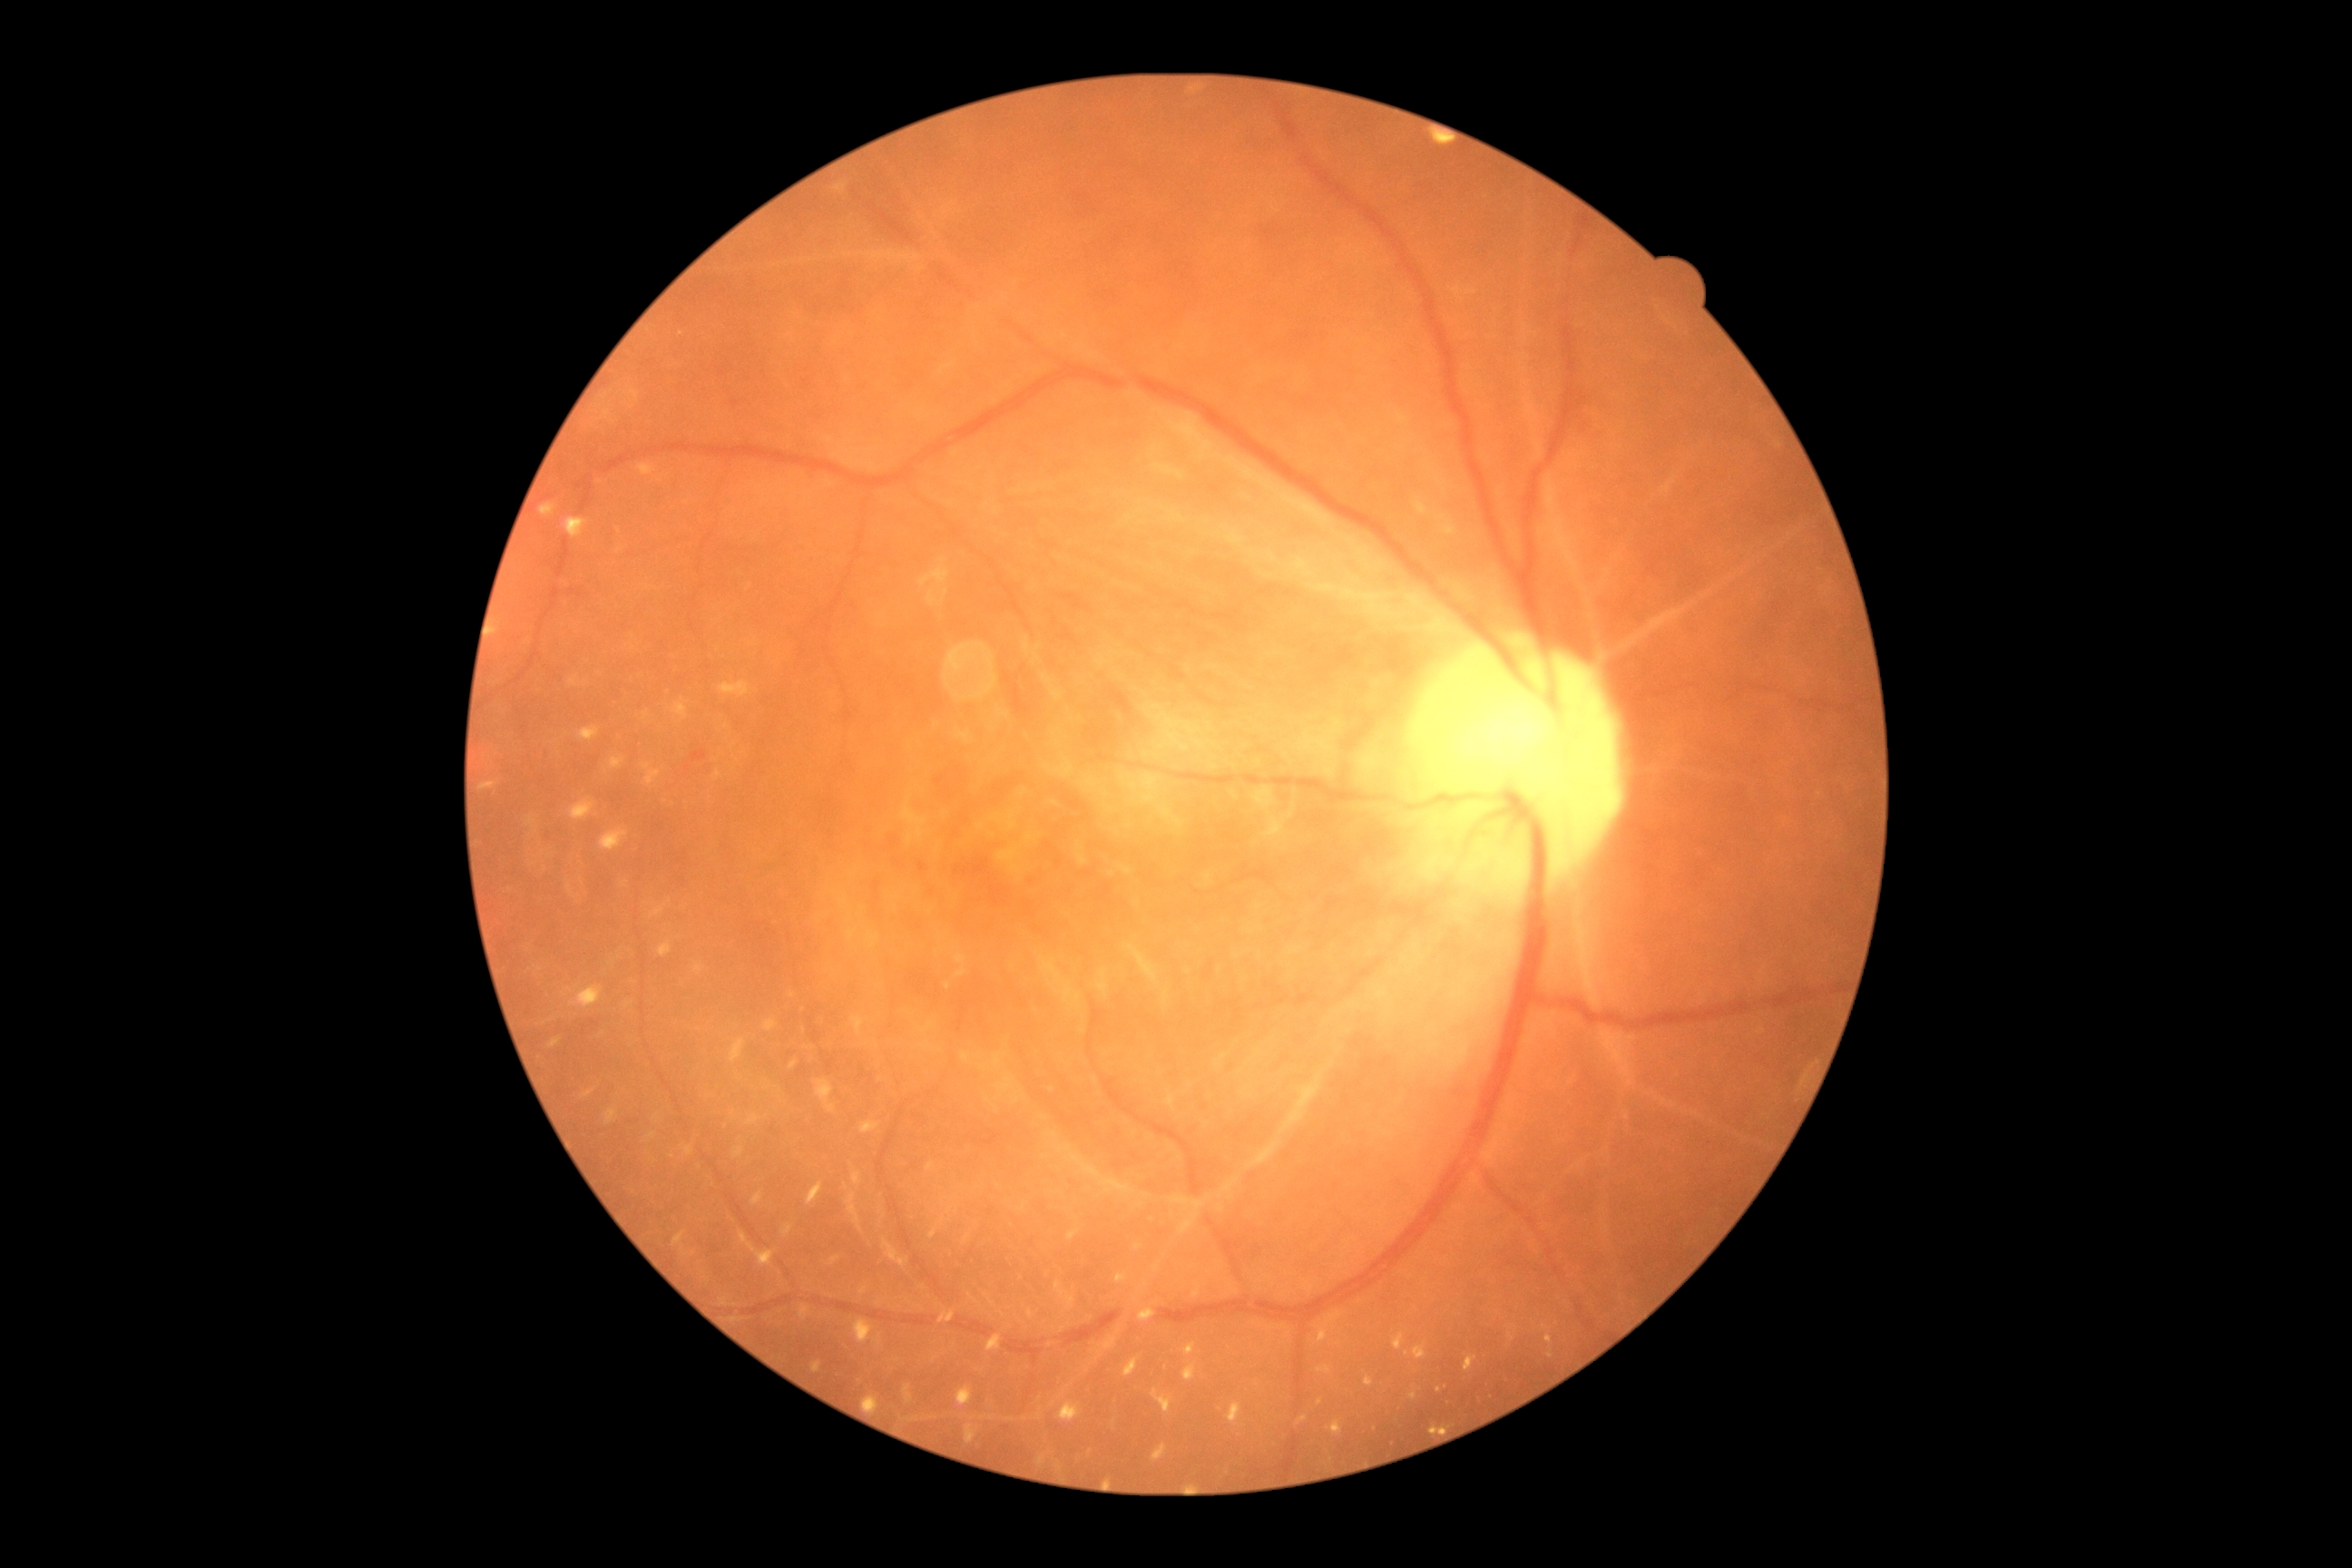
DR stage = 4/4.